Color fundus photograph · 50° FOV · pupil-dilated:
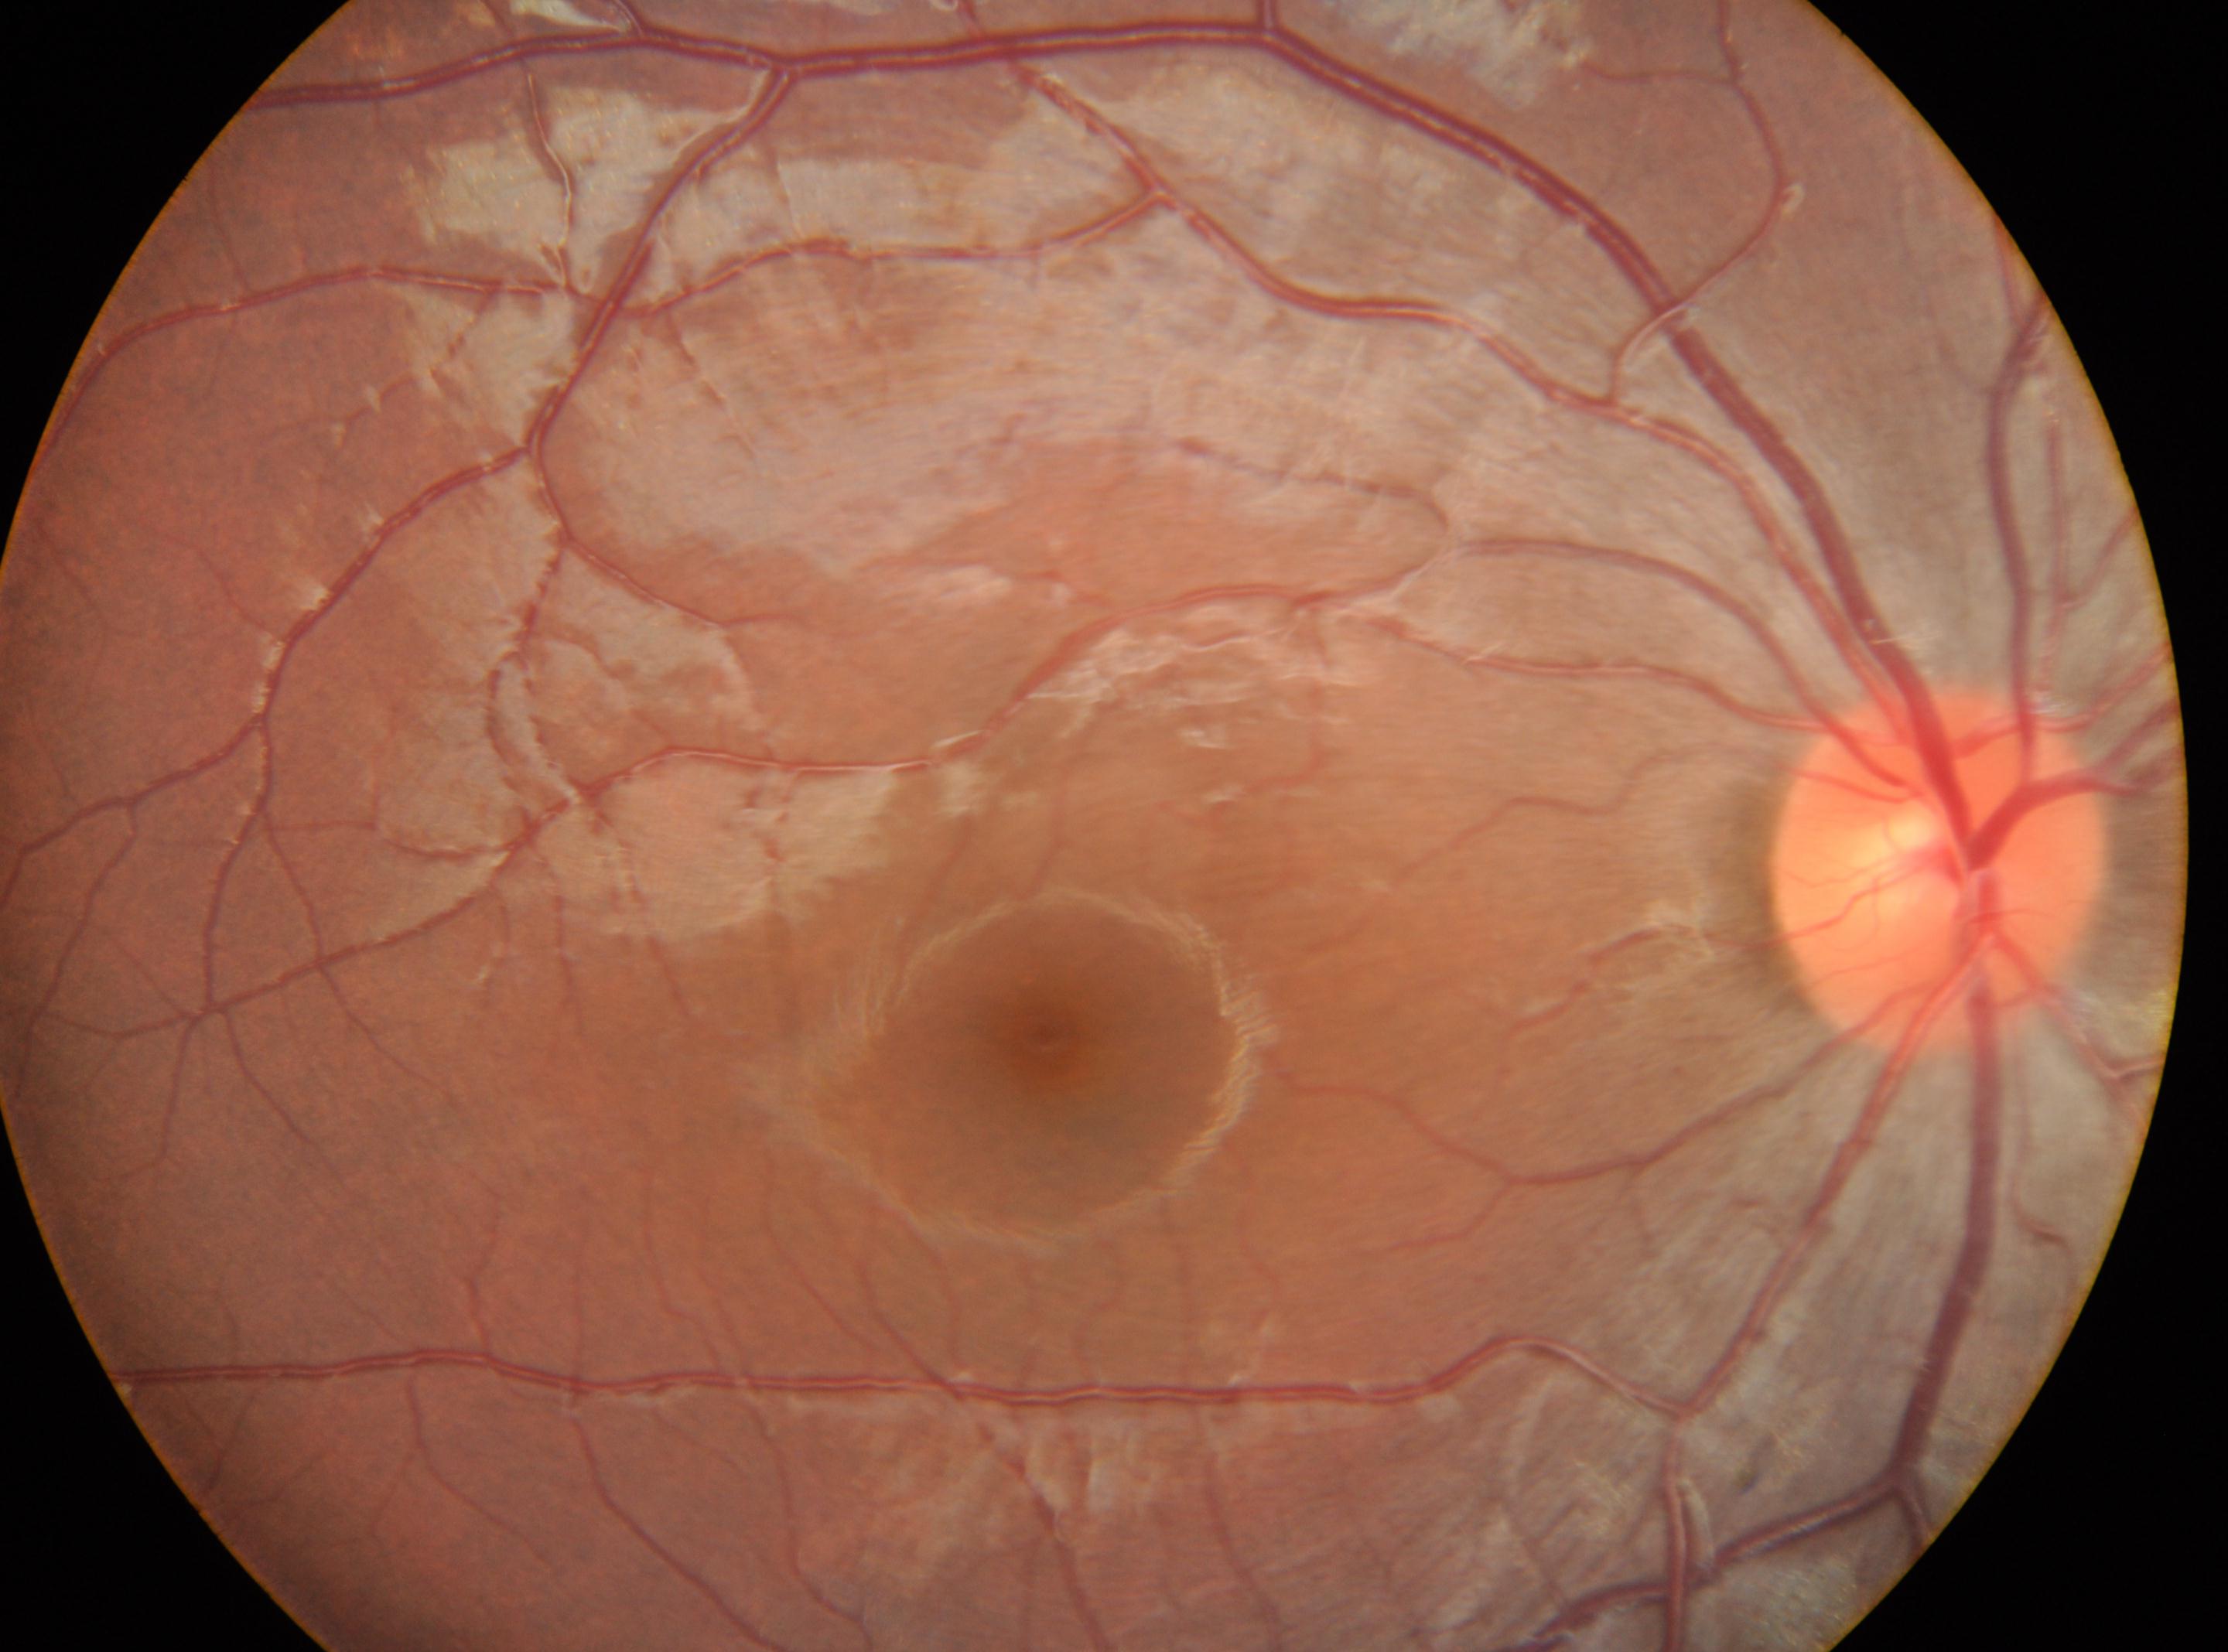

macular center: x=1041, y=1036 | optic nerve head: x=1939, y=866 | diabetic retinopathy severity: 0 | laterality: oculus dexter.